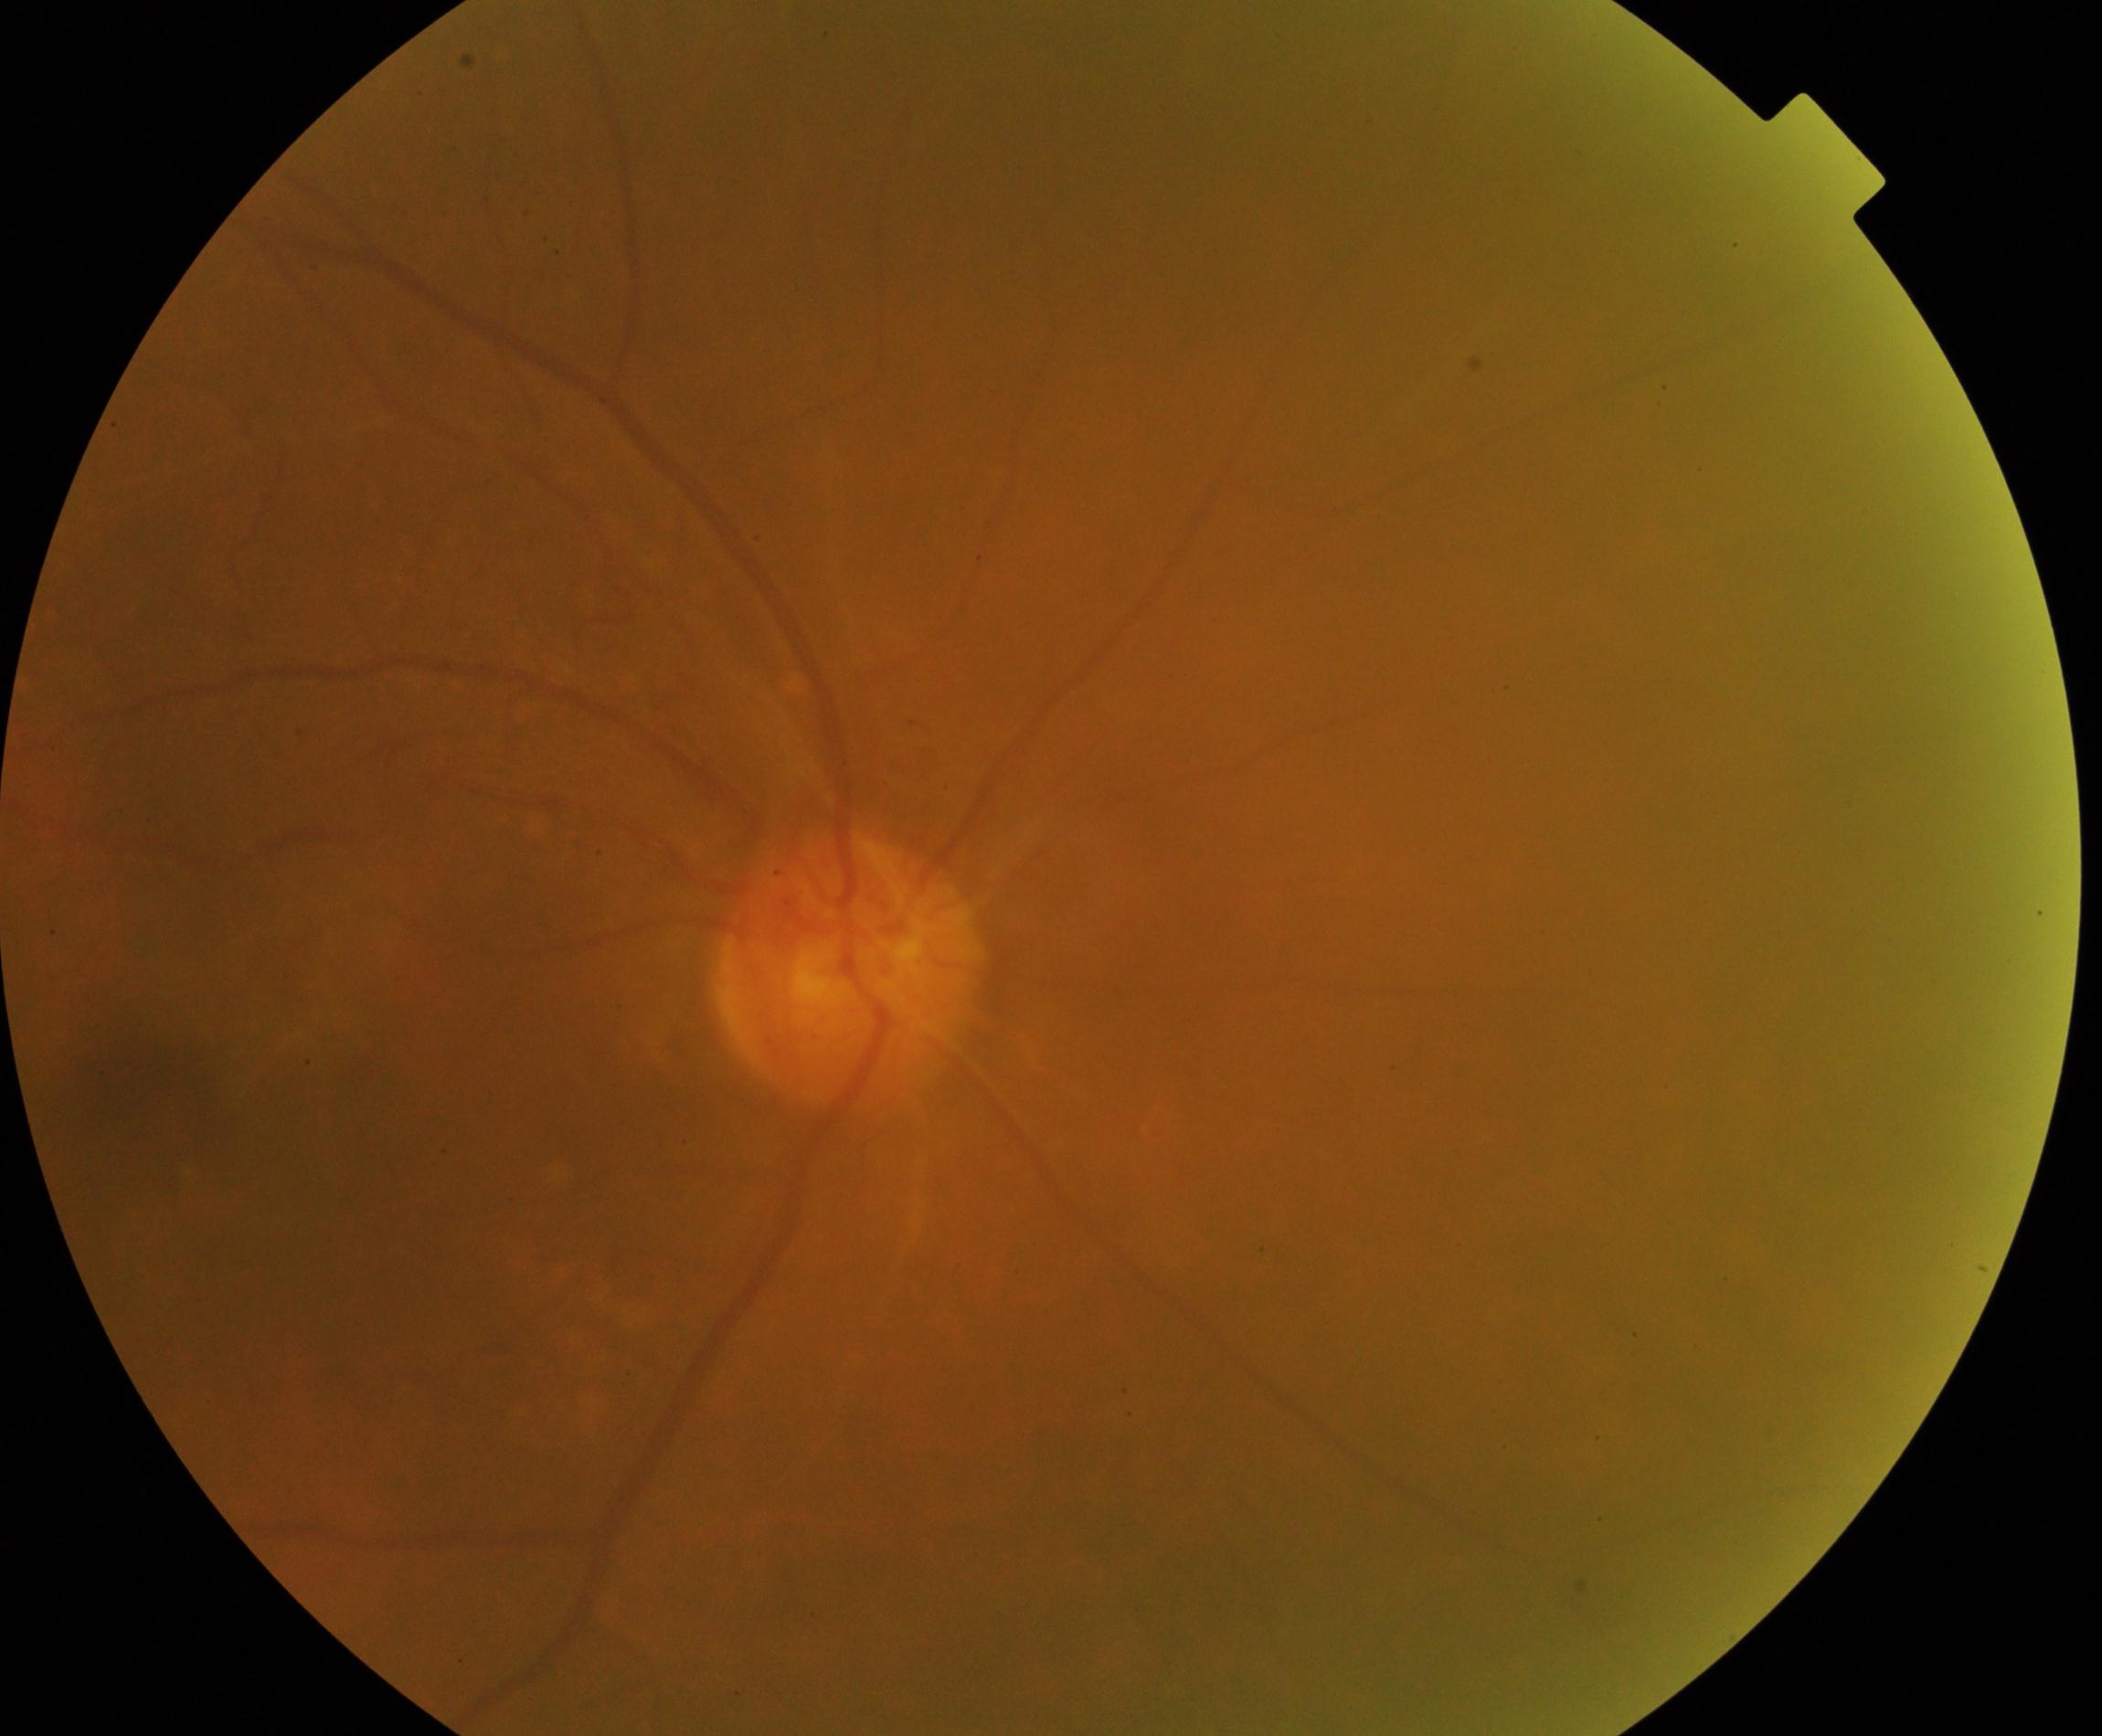

Quality: poor.
Proliferative retinopathy: no evidence.